Posterior pole photograph. 848 by 848 pixels. Without pupil dilation. 45° FOV. Acquired with a NIDEK AFC-230: 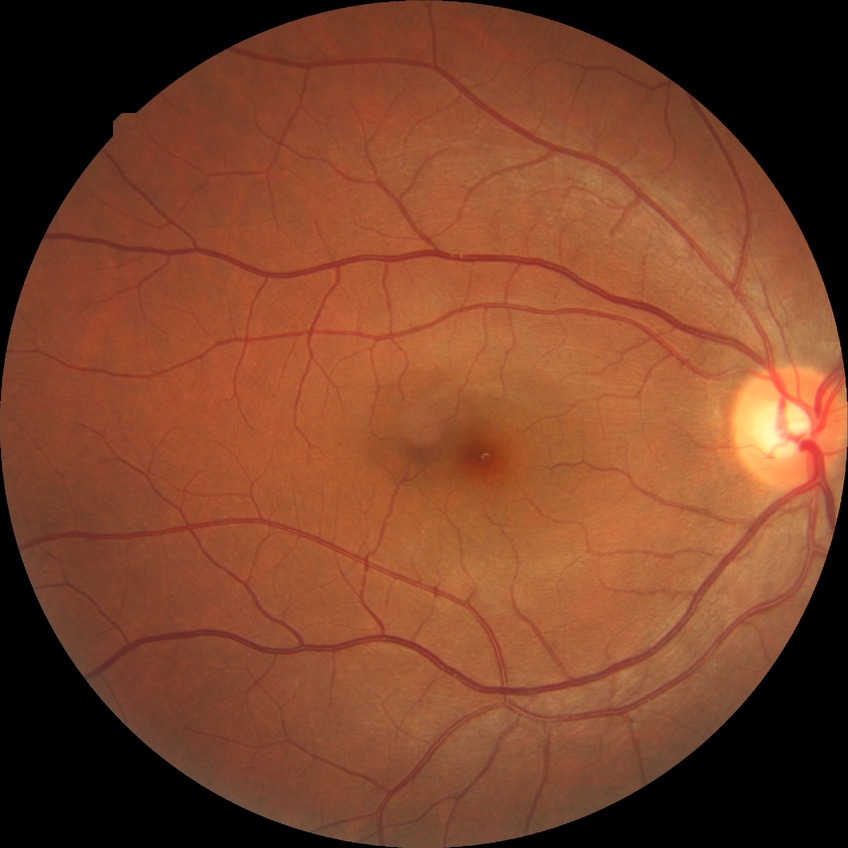

modified Davis classification: no diabetic retinopathy.